45-degree field of view:
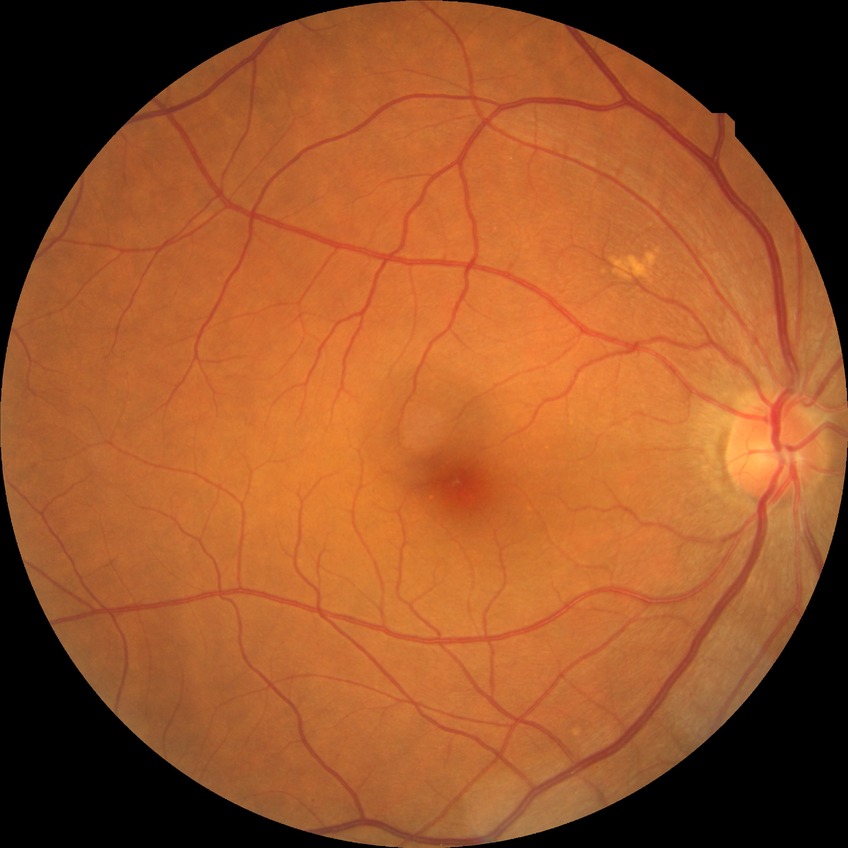

davis_grade: no diabetic retinopathy (NDR)